FOV: 45 degrees — 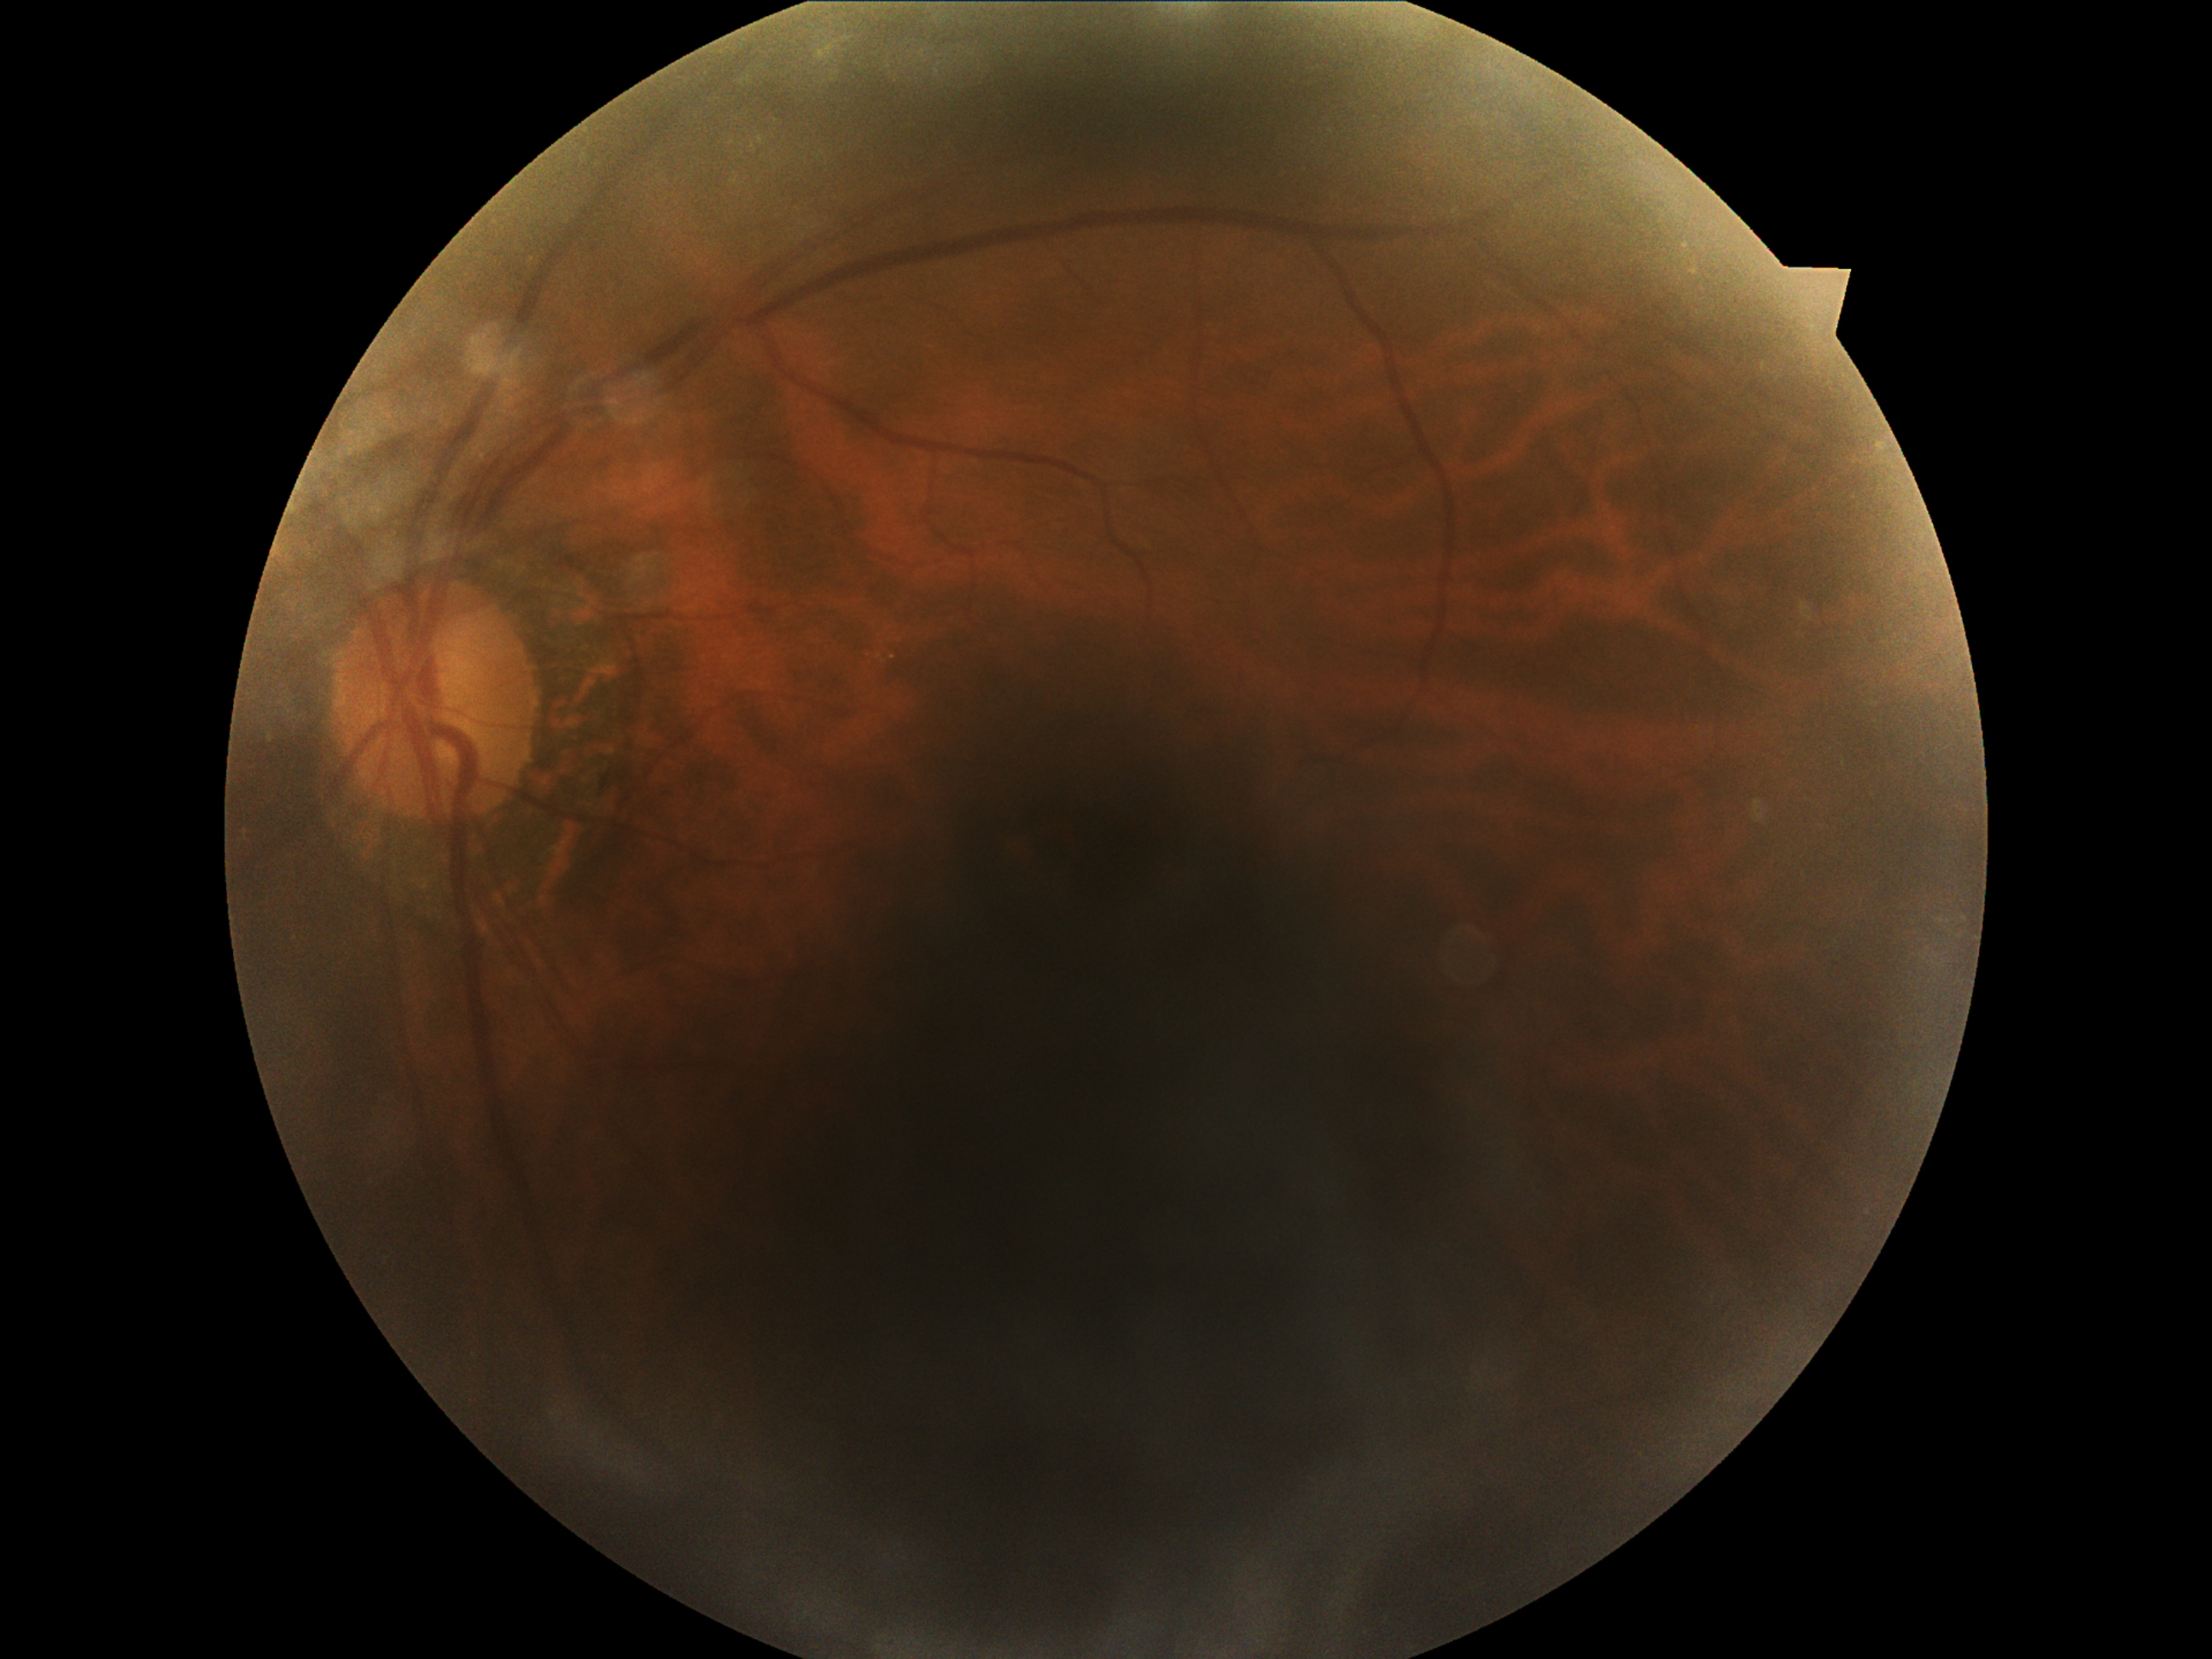

retinopathy: 0/4